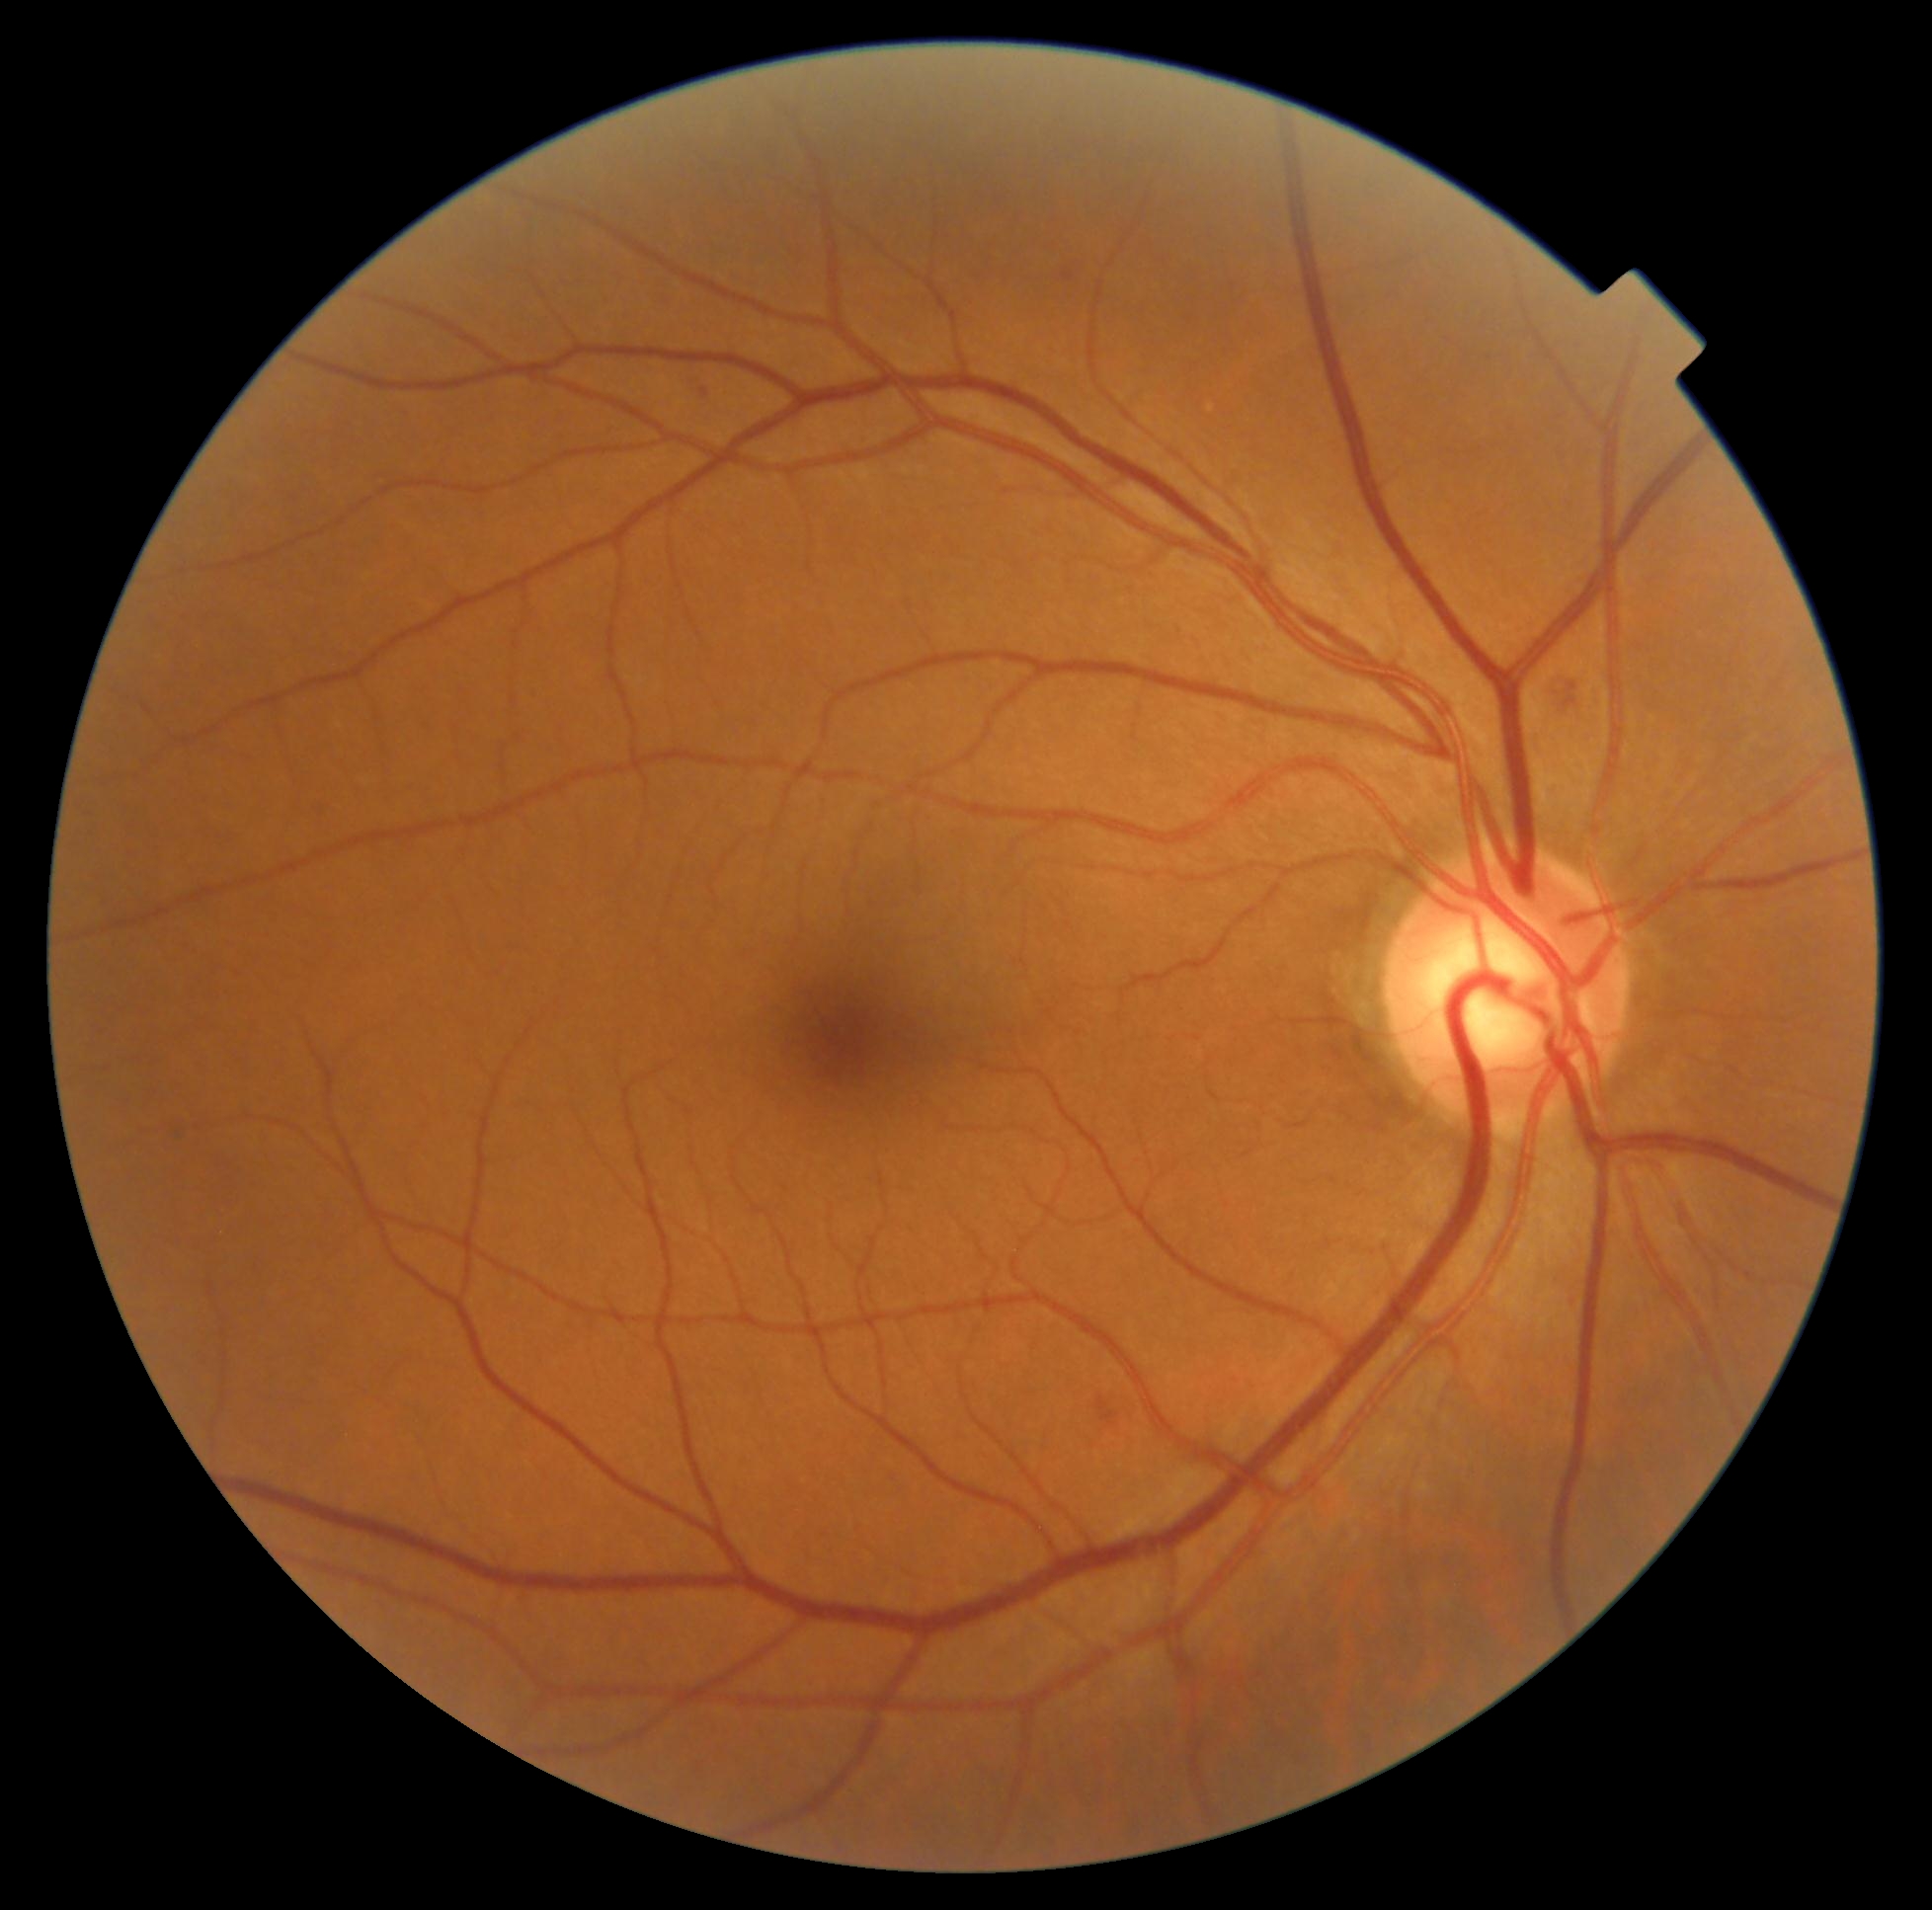 {"dr_grade": "grade 2 — more than just microaneurysms but less than severe NPDR"}